Camera: NIDEK AFC-230. Color fundus photograph. Graded on the modified Davis scale.
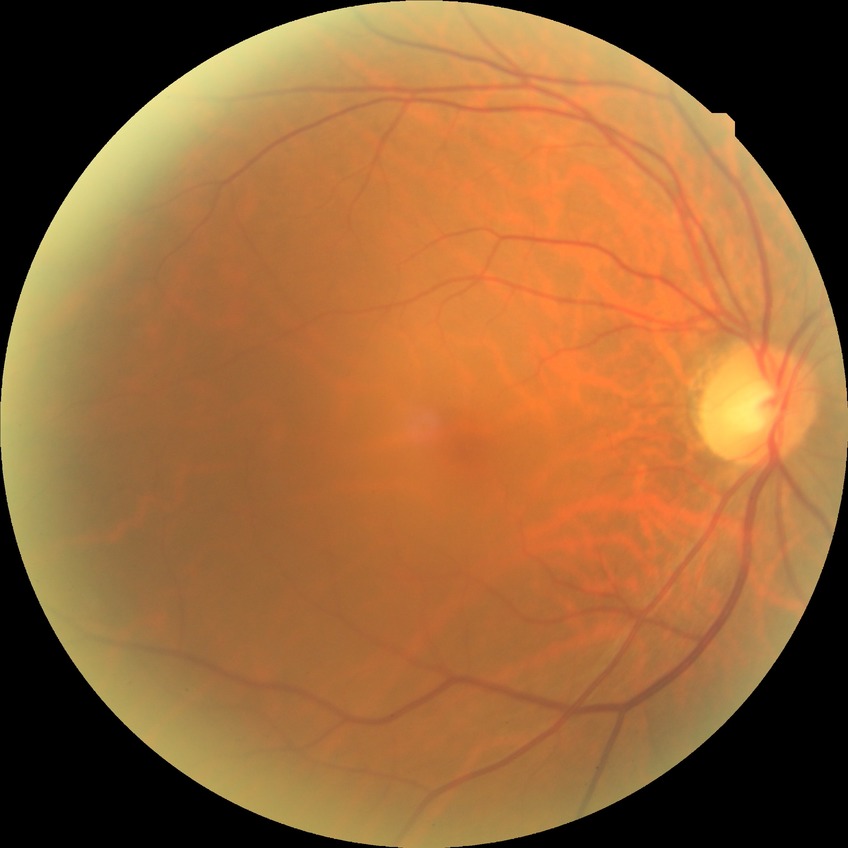 Davis grading = no diabetic retinopathy.